FOV: 45 degrees.
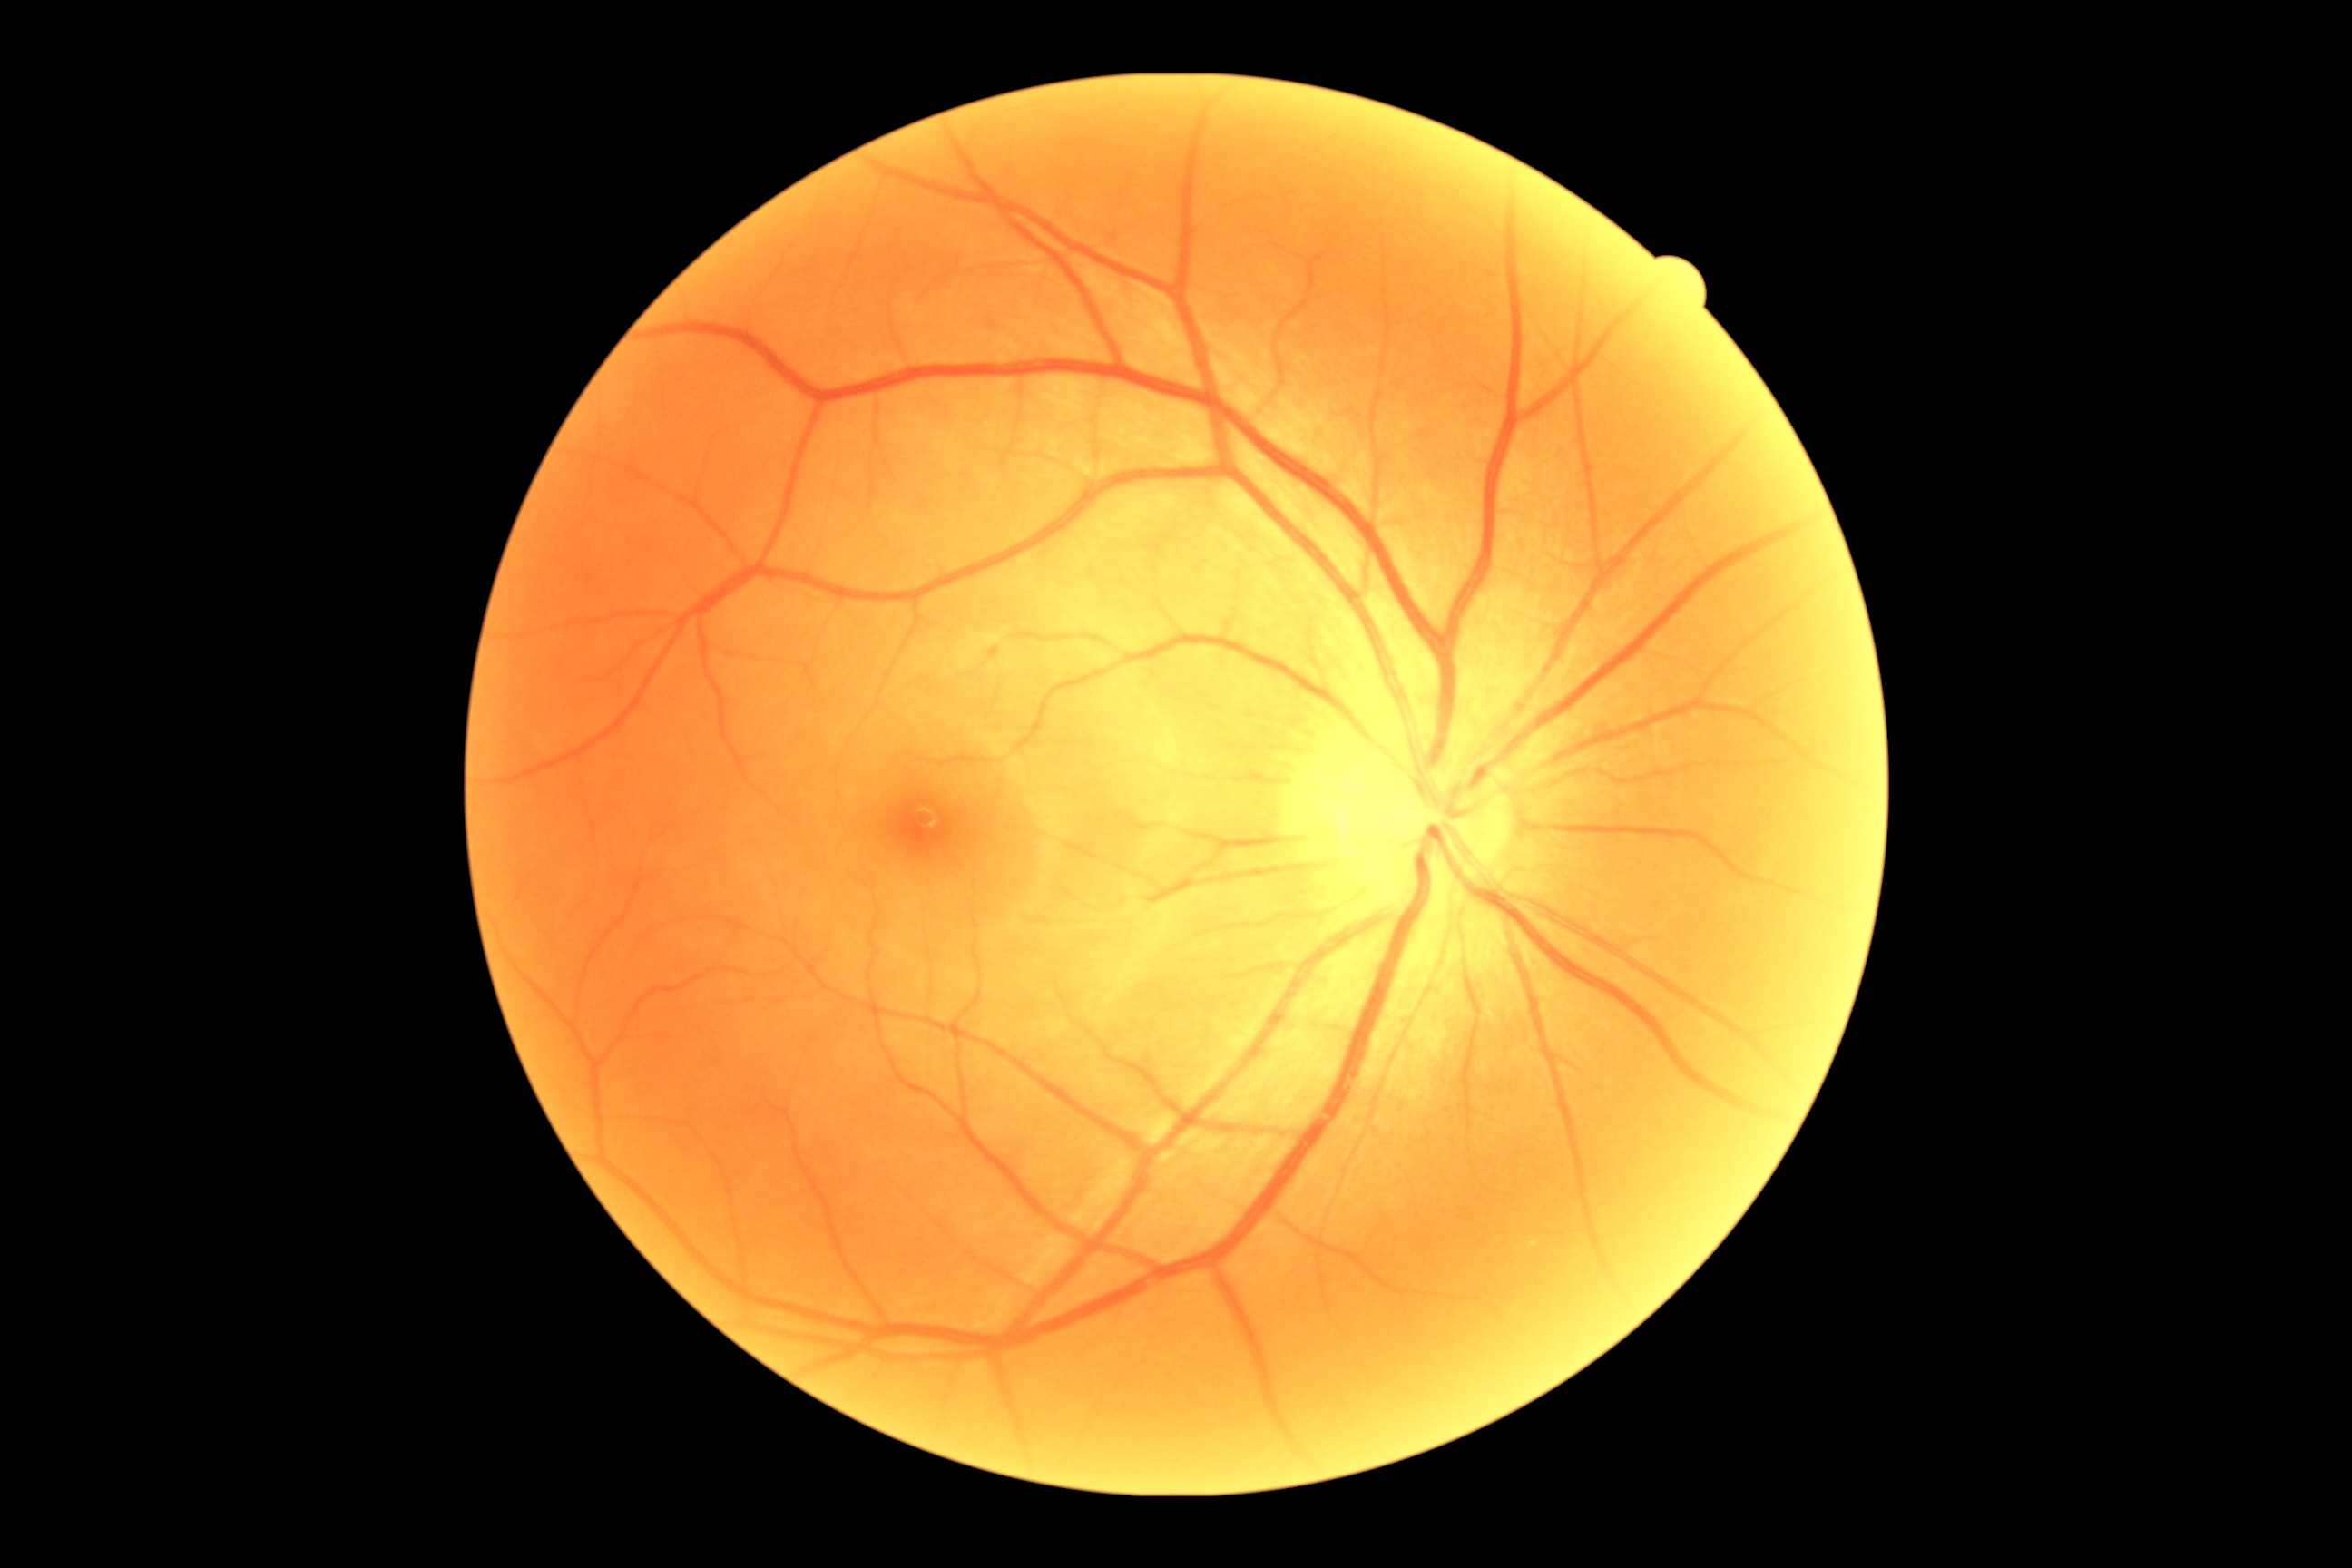

Diabetic retinopathy (DR) is no apparent retinopathy (grade 0).